Image size 1932x1916 — 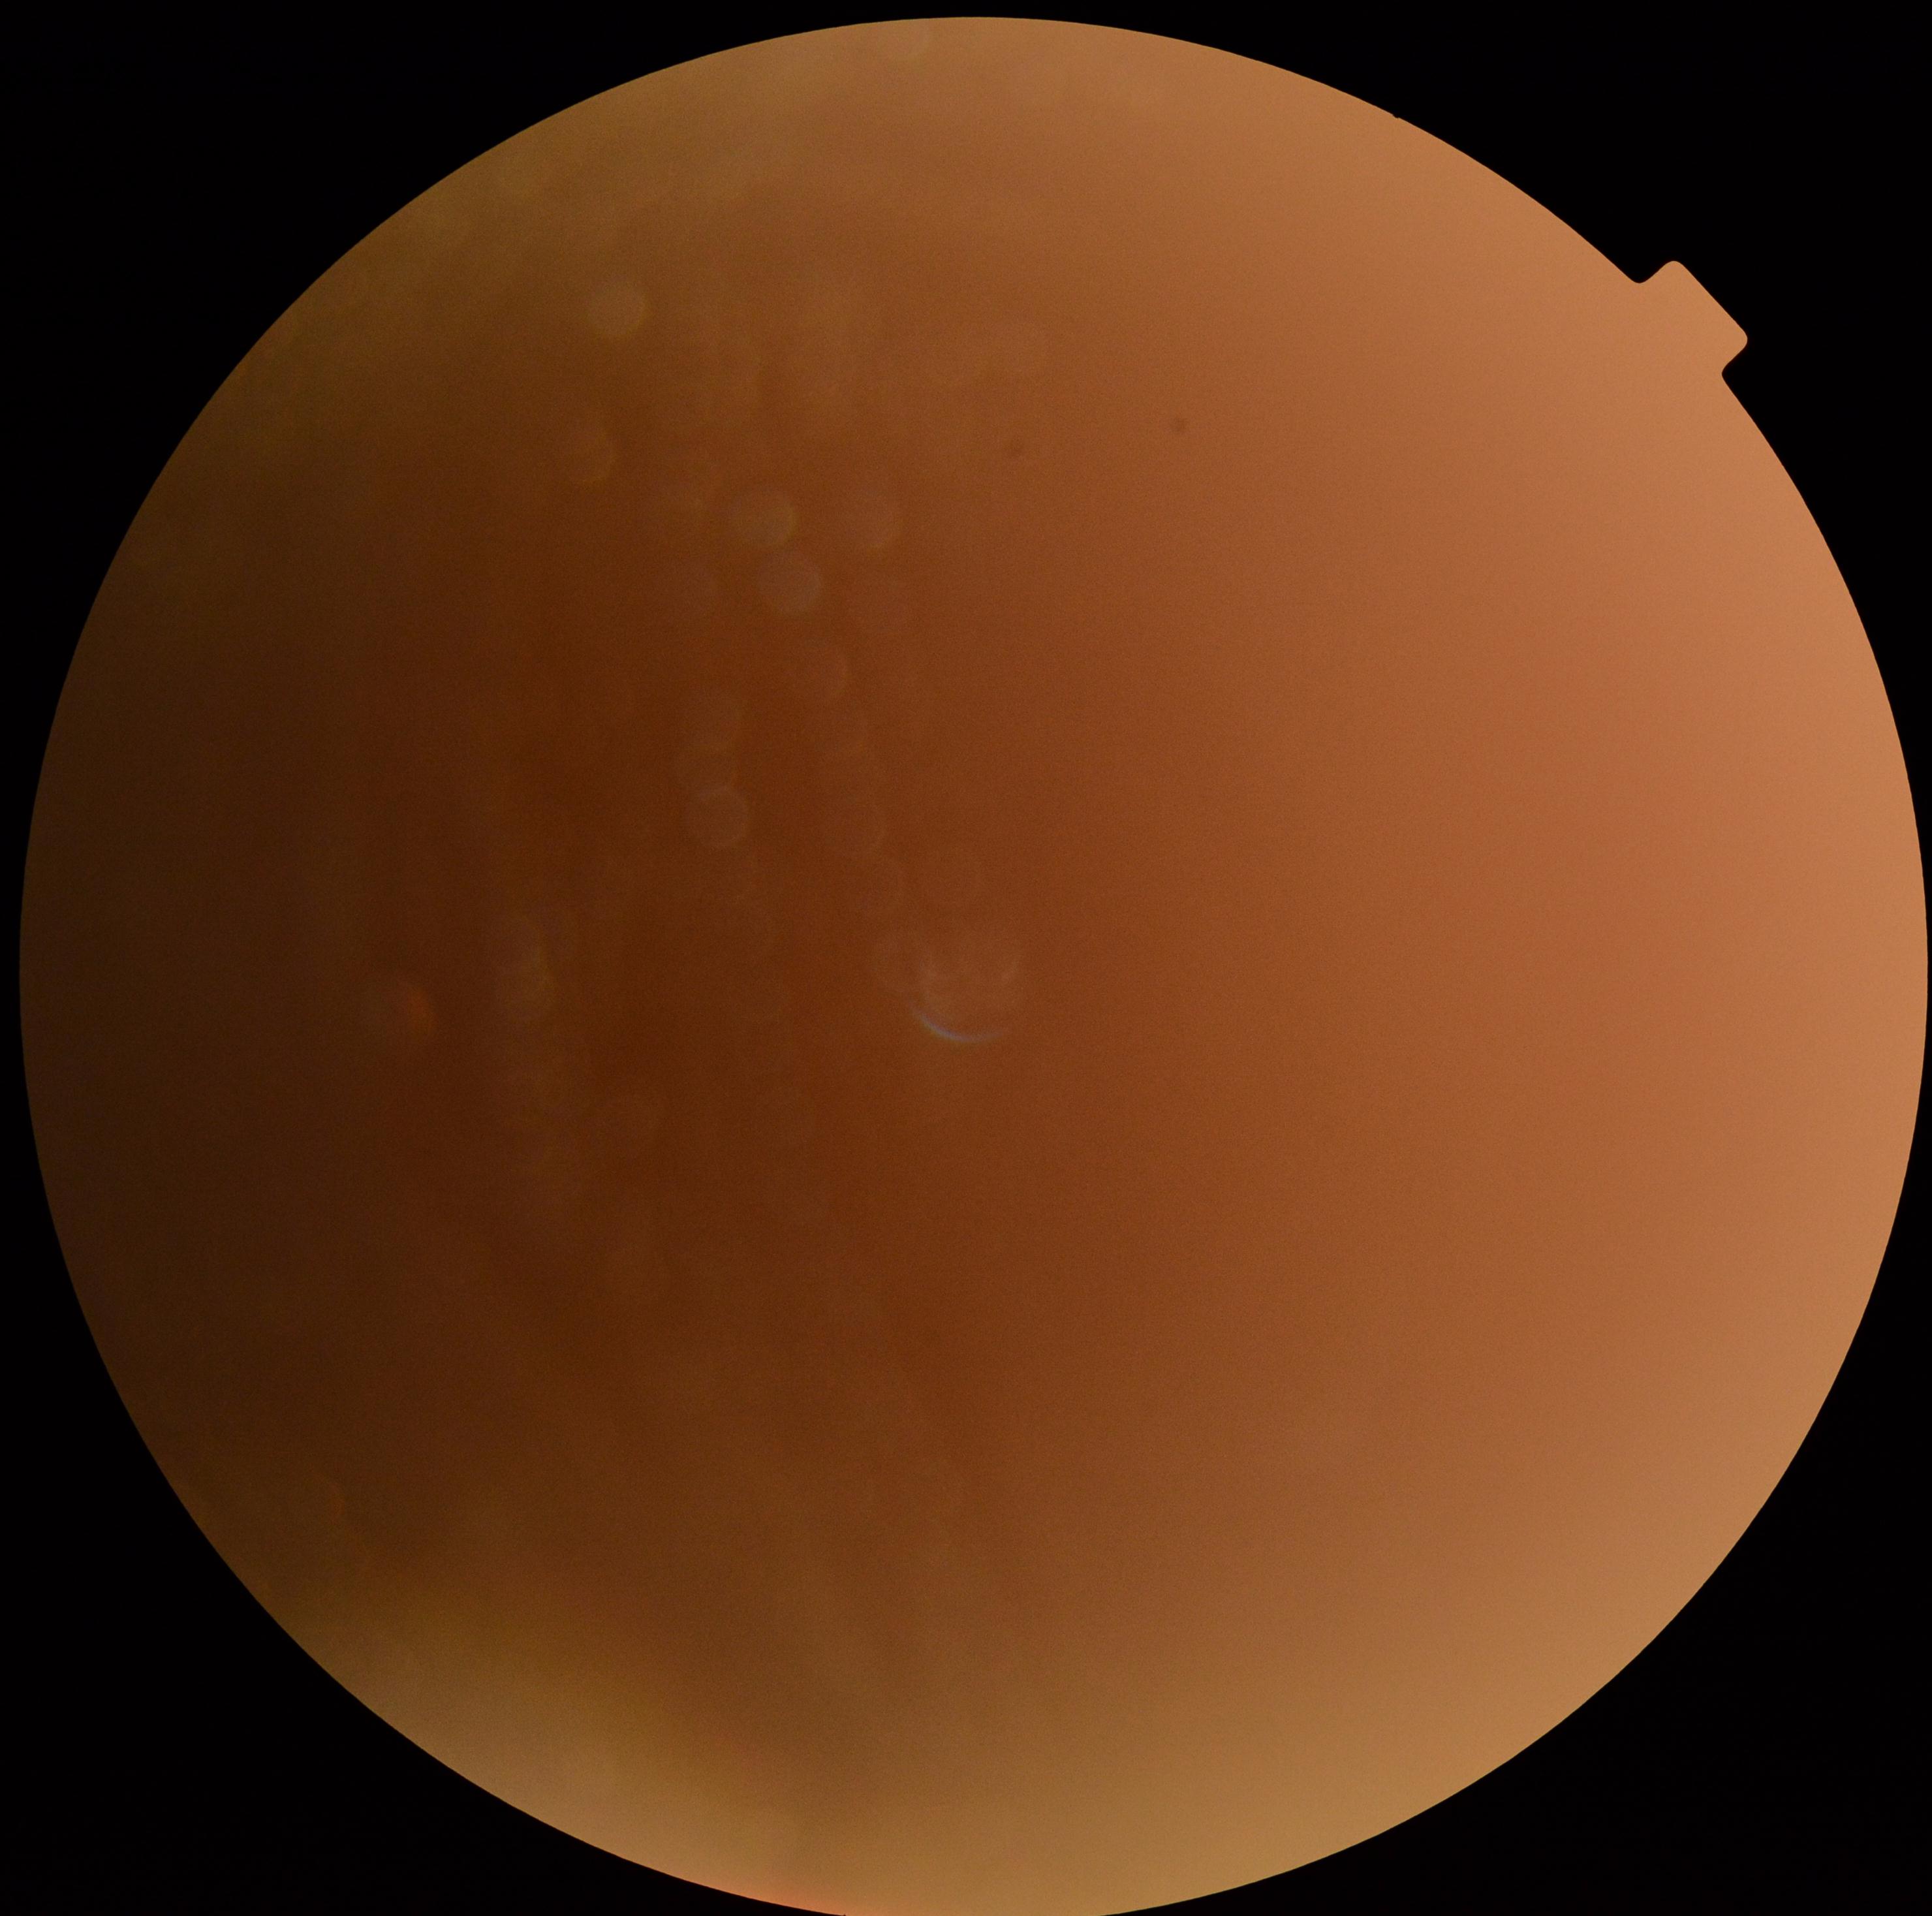 {
  "dr_grade": "ungradable"
}